FOV: 45 degrees, no pharmacologic dilation, diabetic retinopathy graded by the modified Davis classification, acquired with a NIDEK AFC-230, CFP
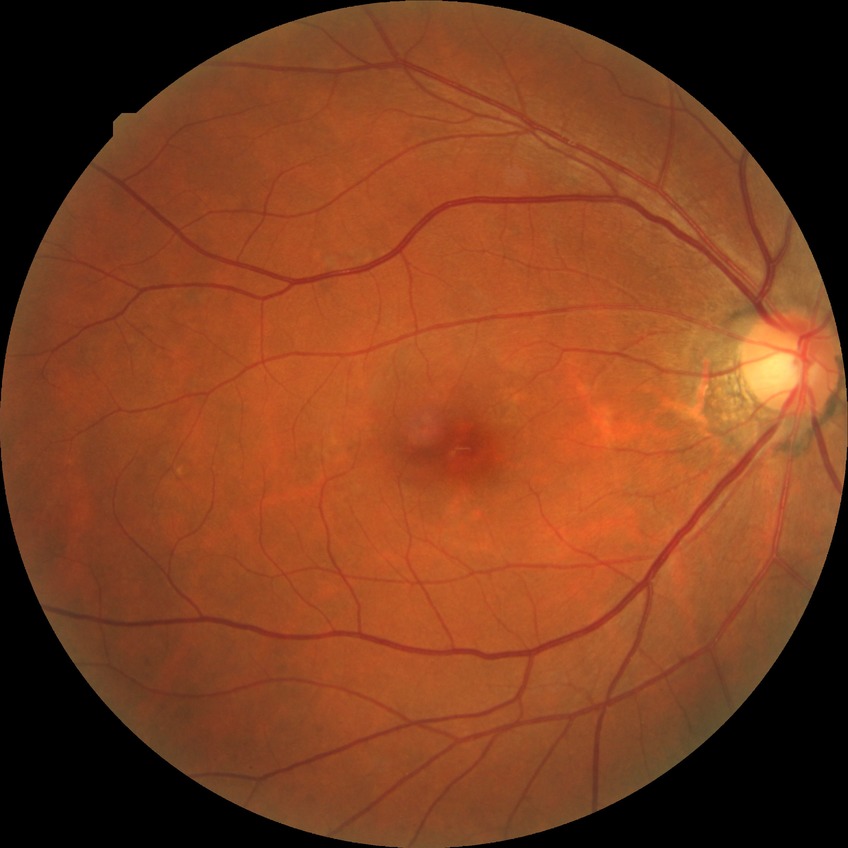 Davis grading is no diabetic retinopathy.